Without pupil dilation · NIDEK AFC-230 fundus camera · 45° field of view · posterior pole photograph · 848 by 848 pixels
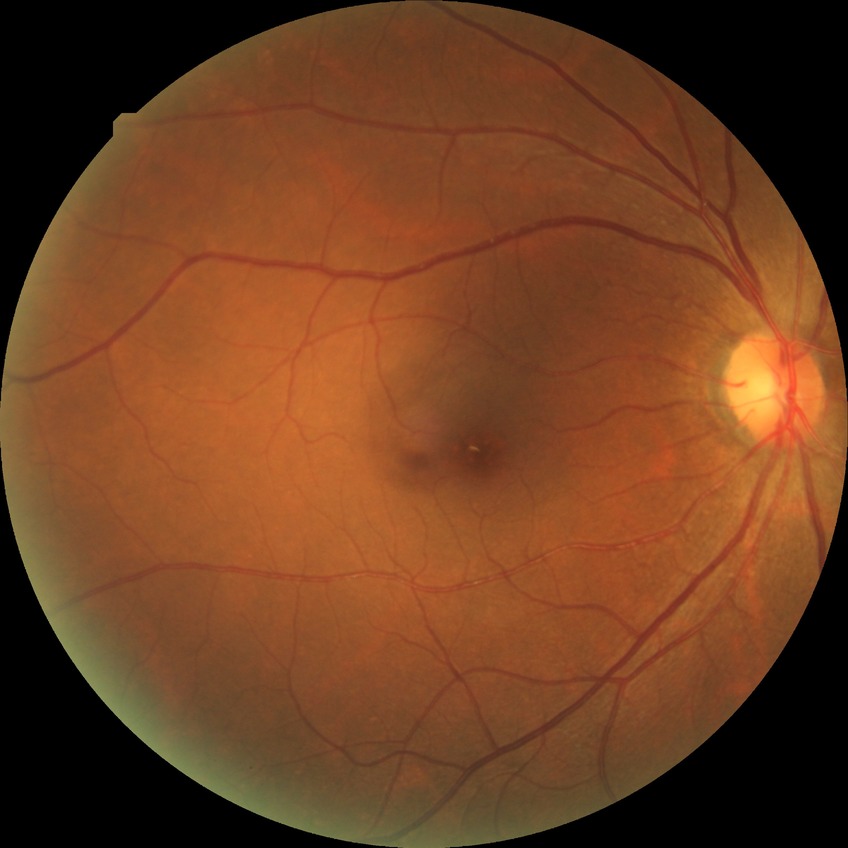

DR grade is NDR.